Acquired with a Remidio FOP fundus camera.
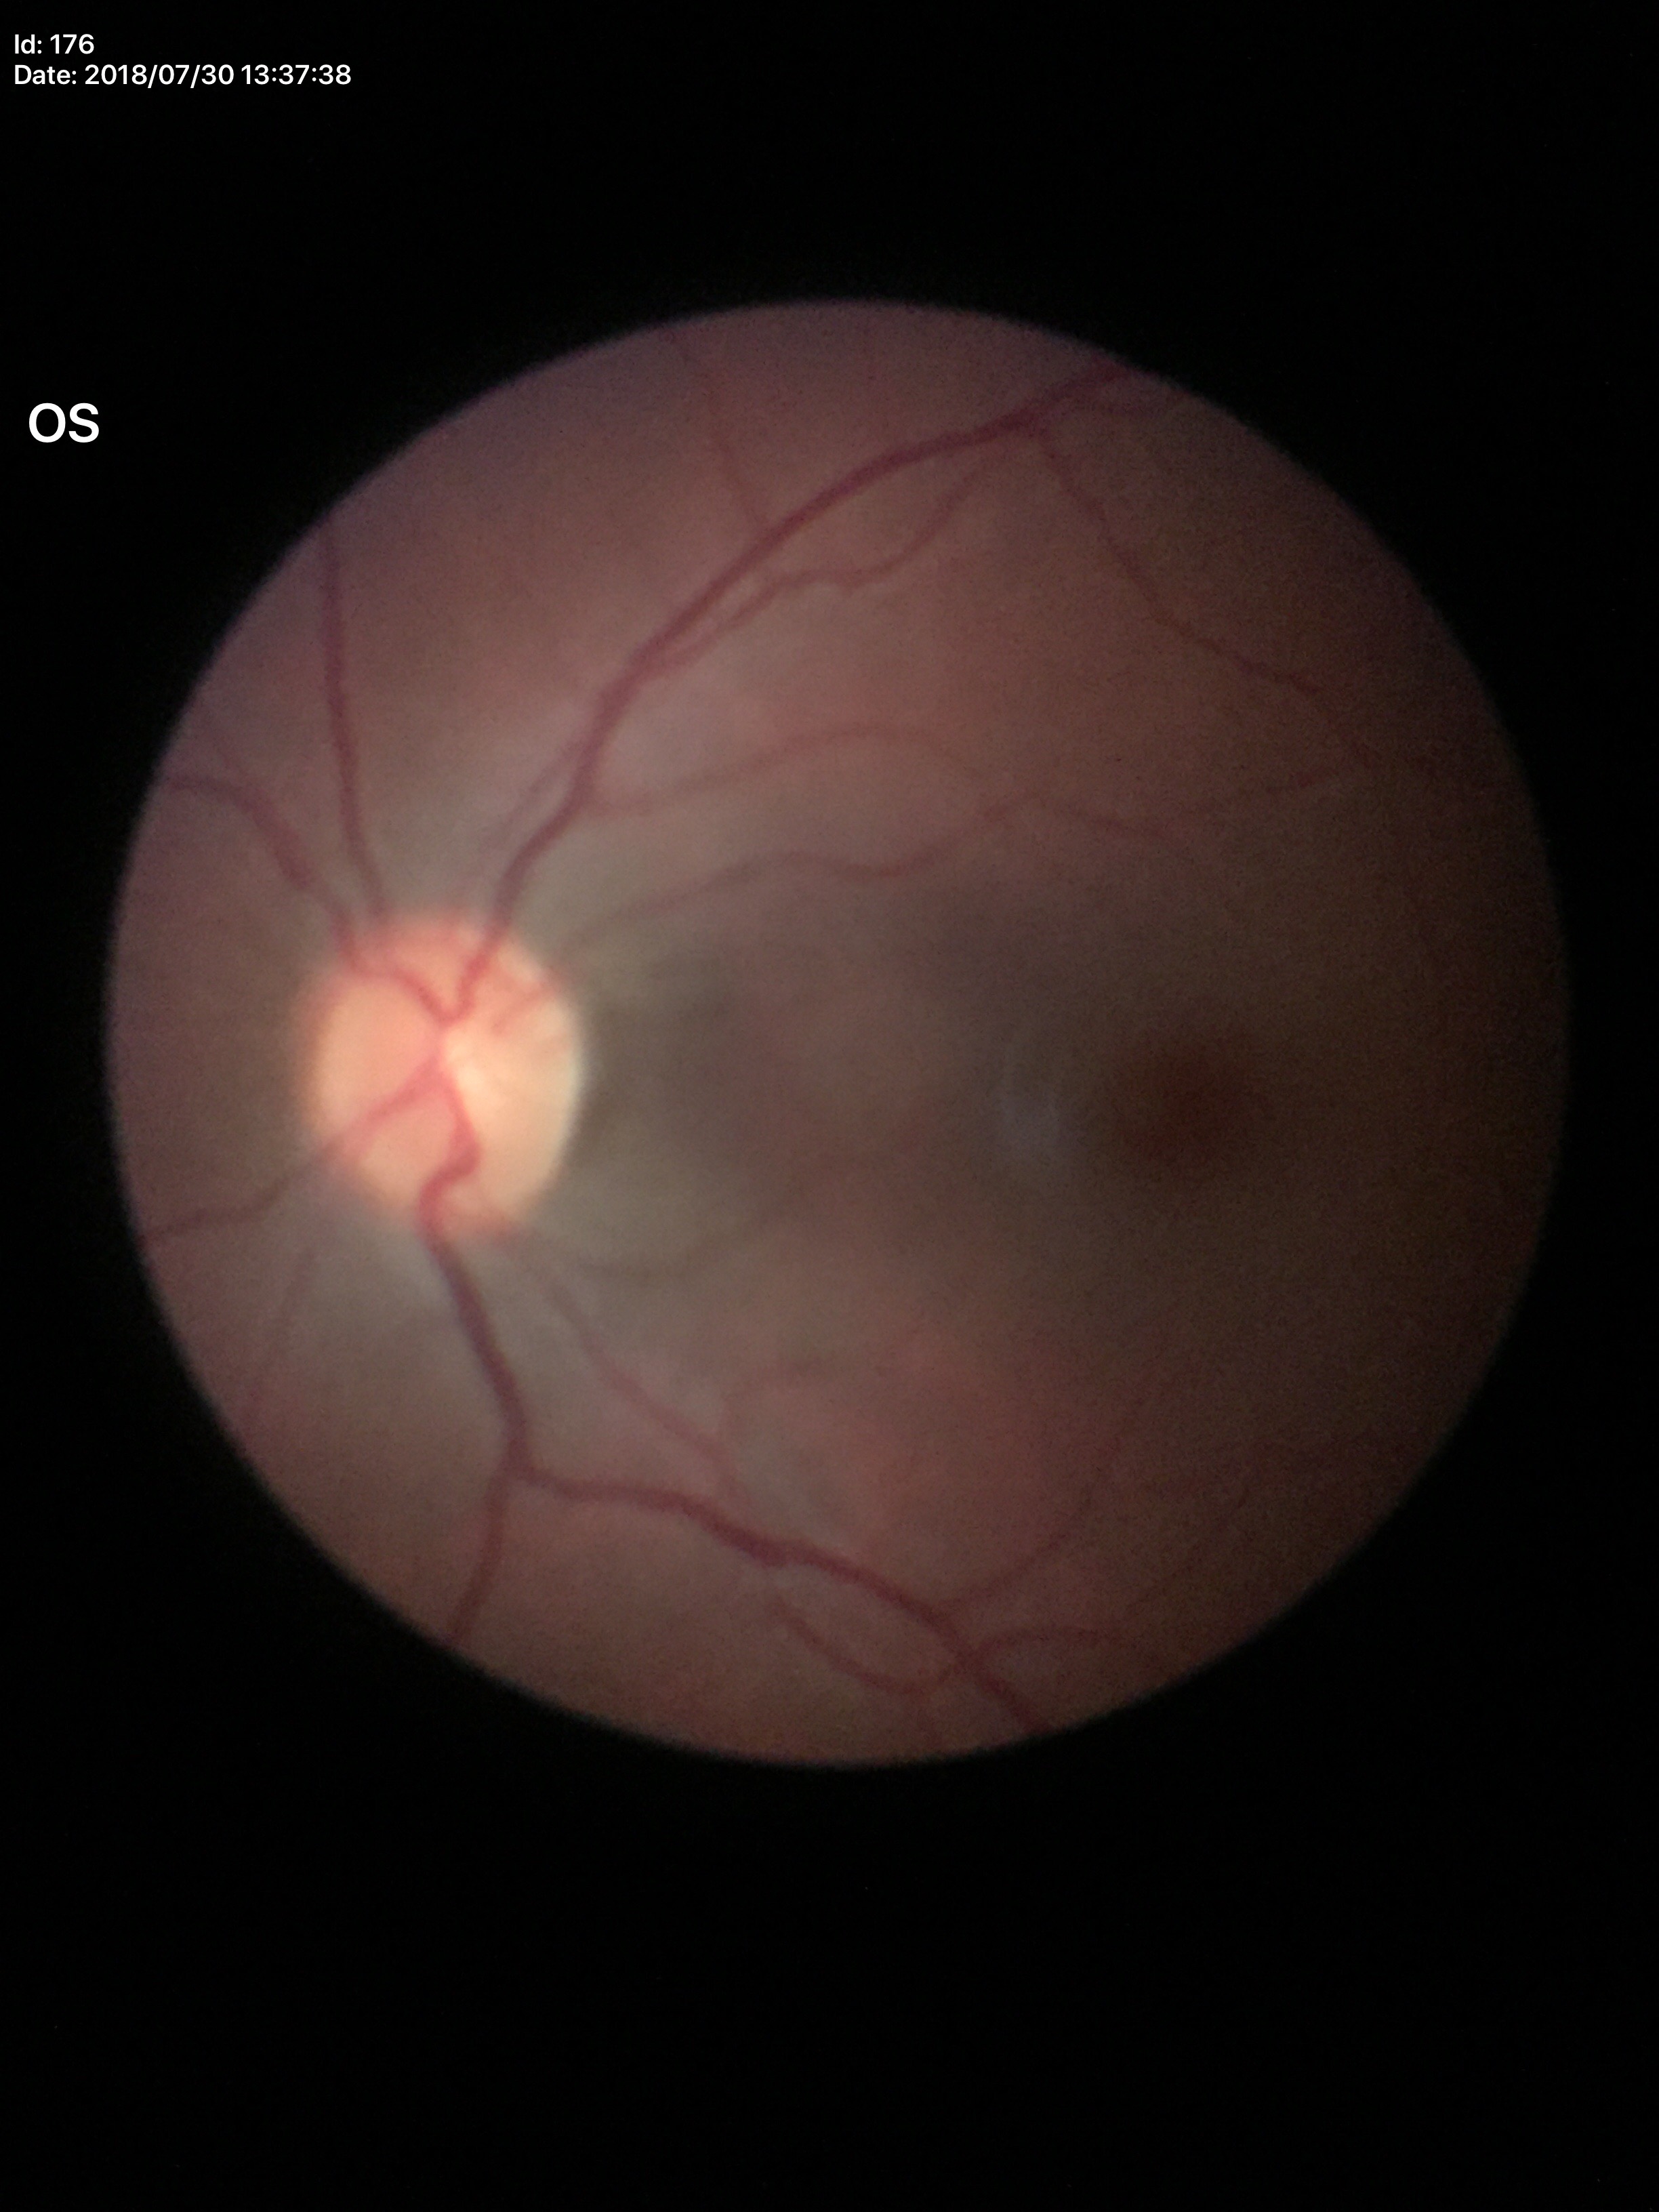
– vertical cup-disc ratio: 0.42
– Glaucoma impression: not suspect
– area C/D ratio: 0.17